Wide-field contact fundus photograph of an infant · 640x480 · 130° field of view (Clarity RetCam 3): 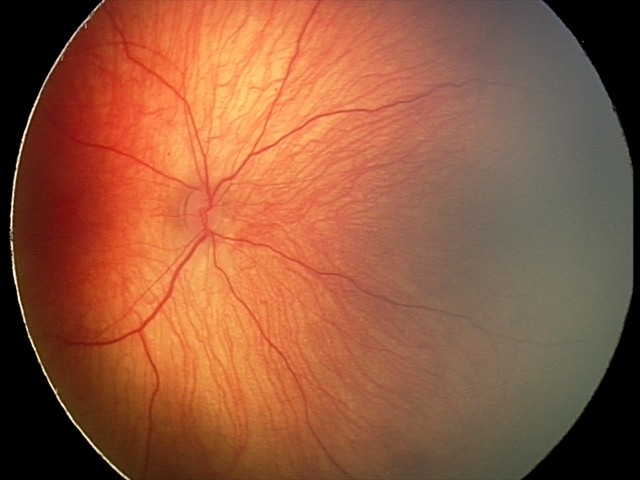
Finding = retinal hemorrhages.